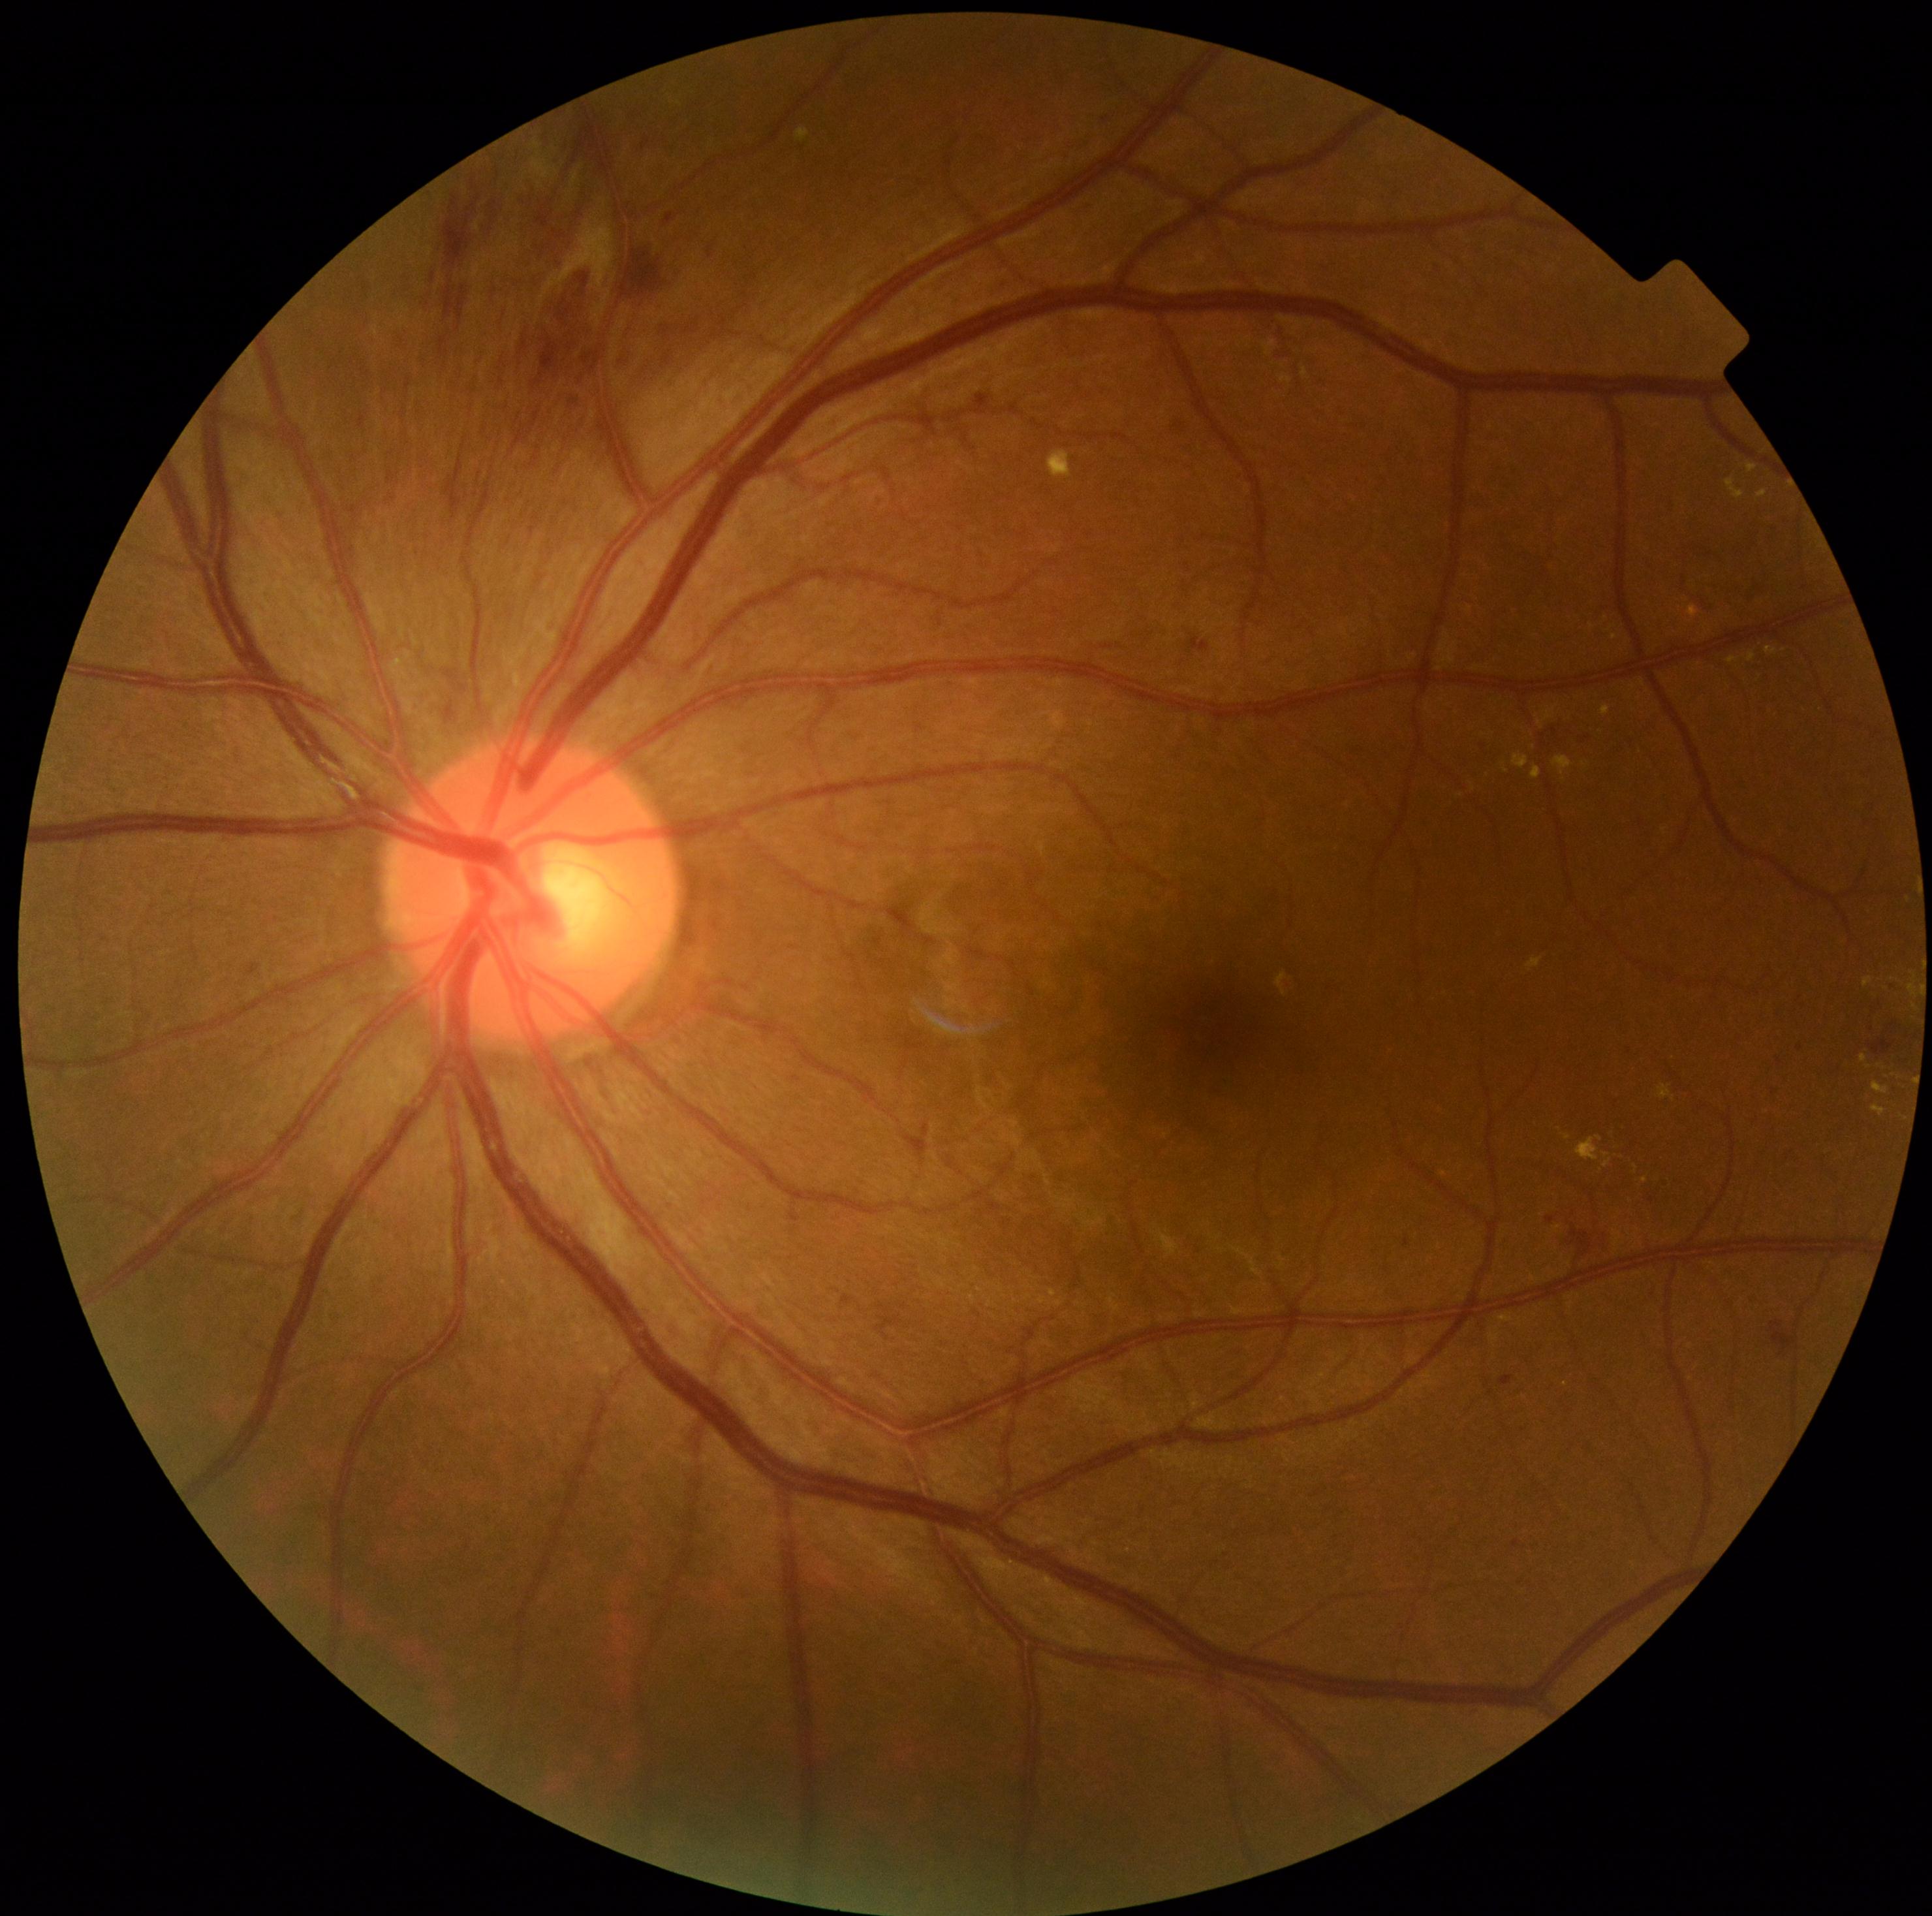

Diabetic retinopathy grade is moderate non-proliferative diabetic retinopathy (2).
The retinopathy is classified as non-proliferative diabetic retinopathy.